Modified Davis grading
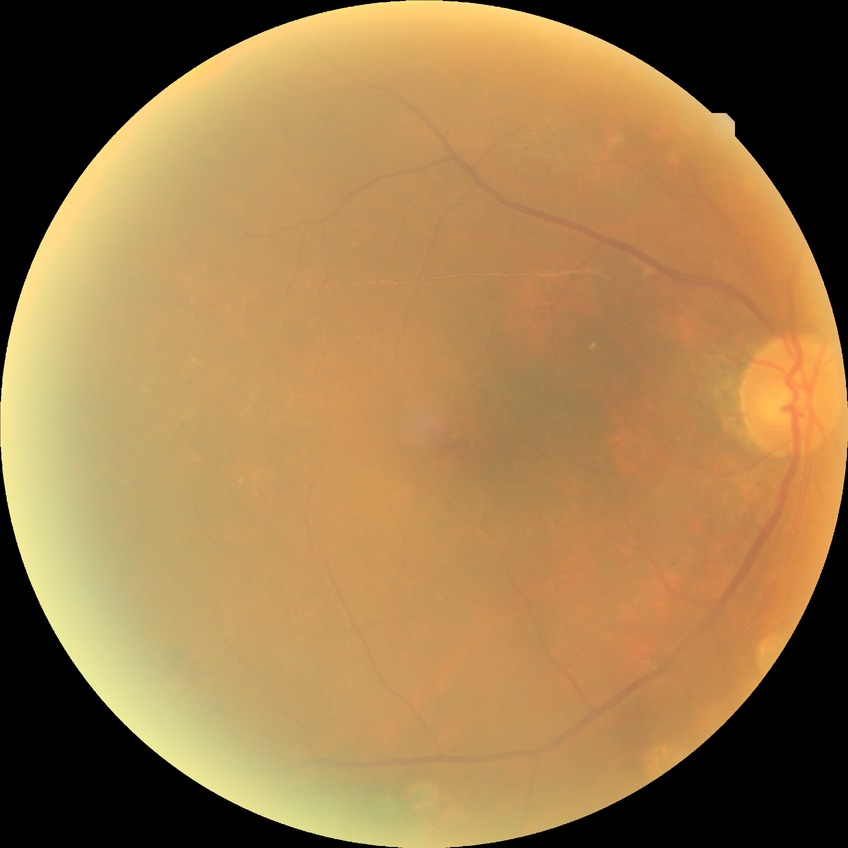

Diabetic retinopathy grade is proliferative diabetic retinopathy.